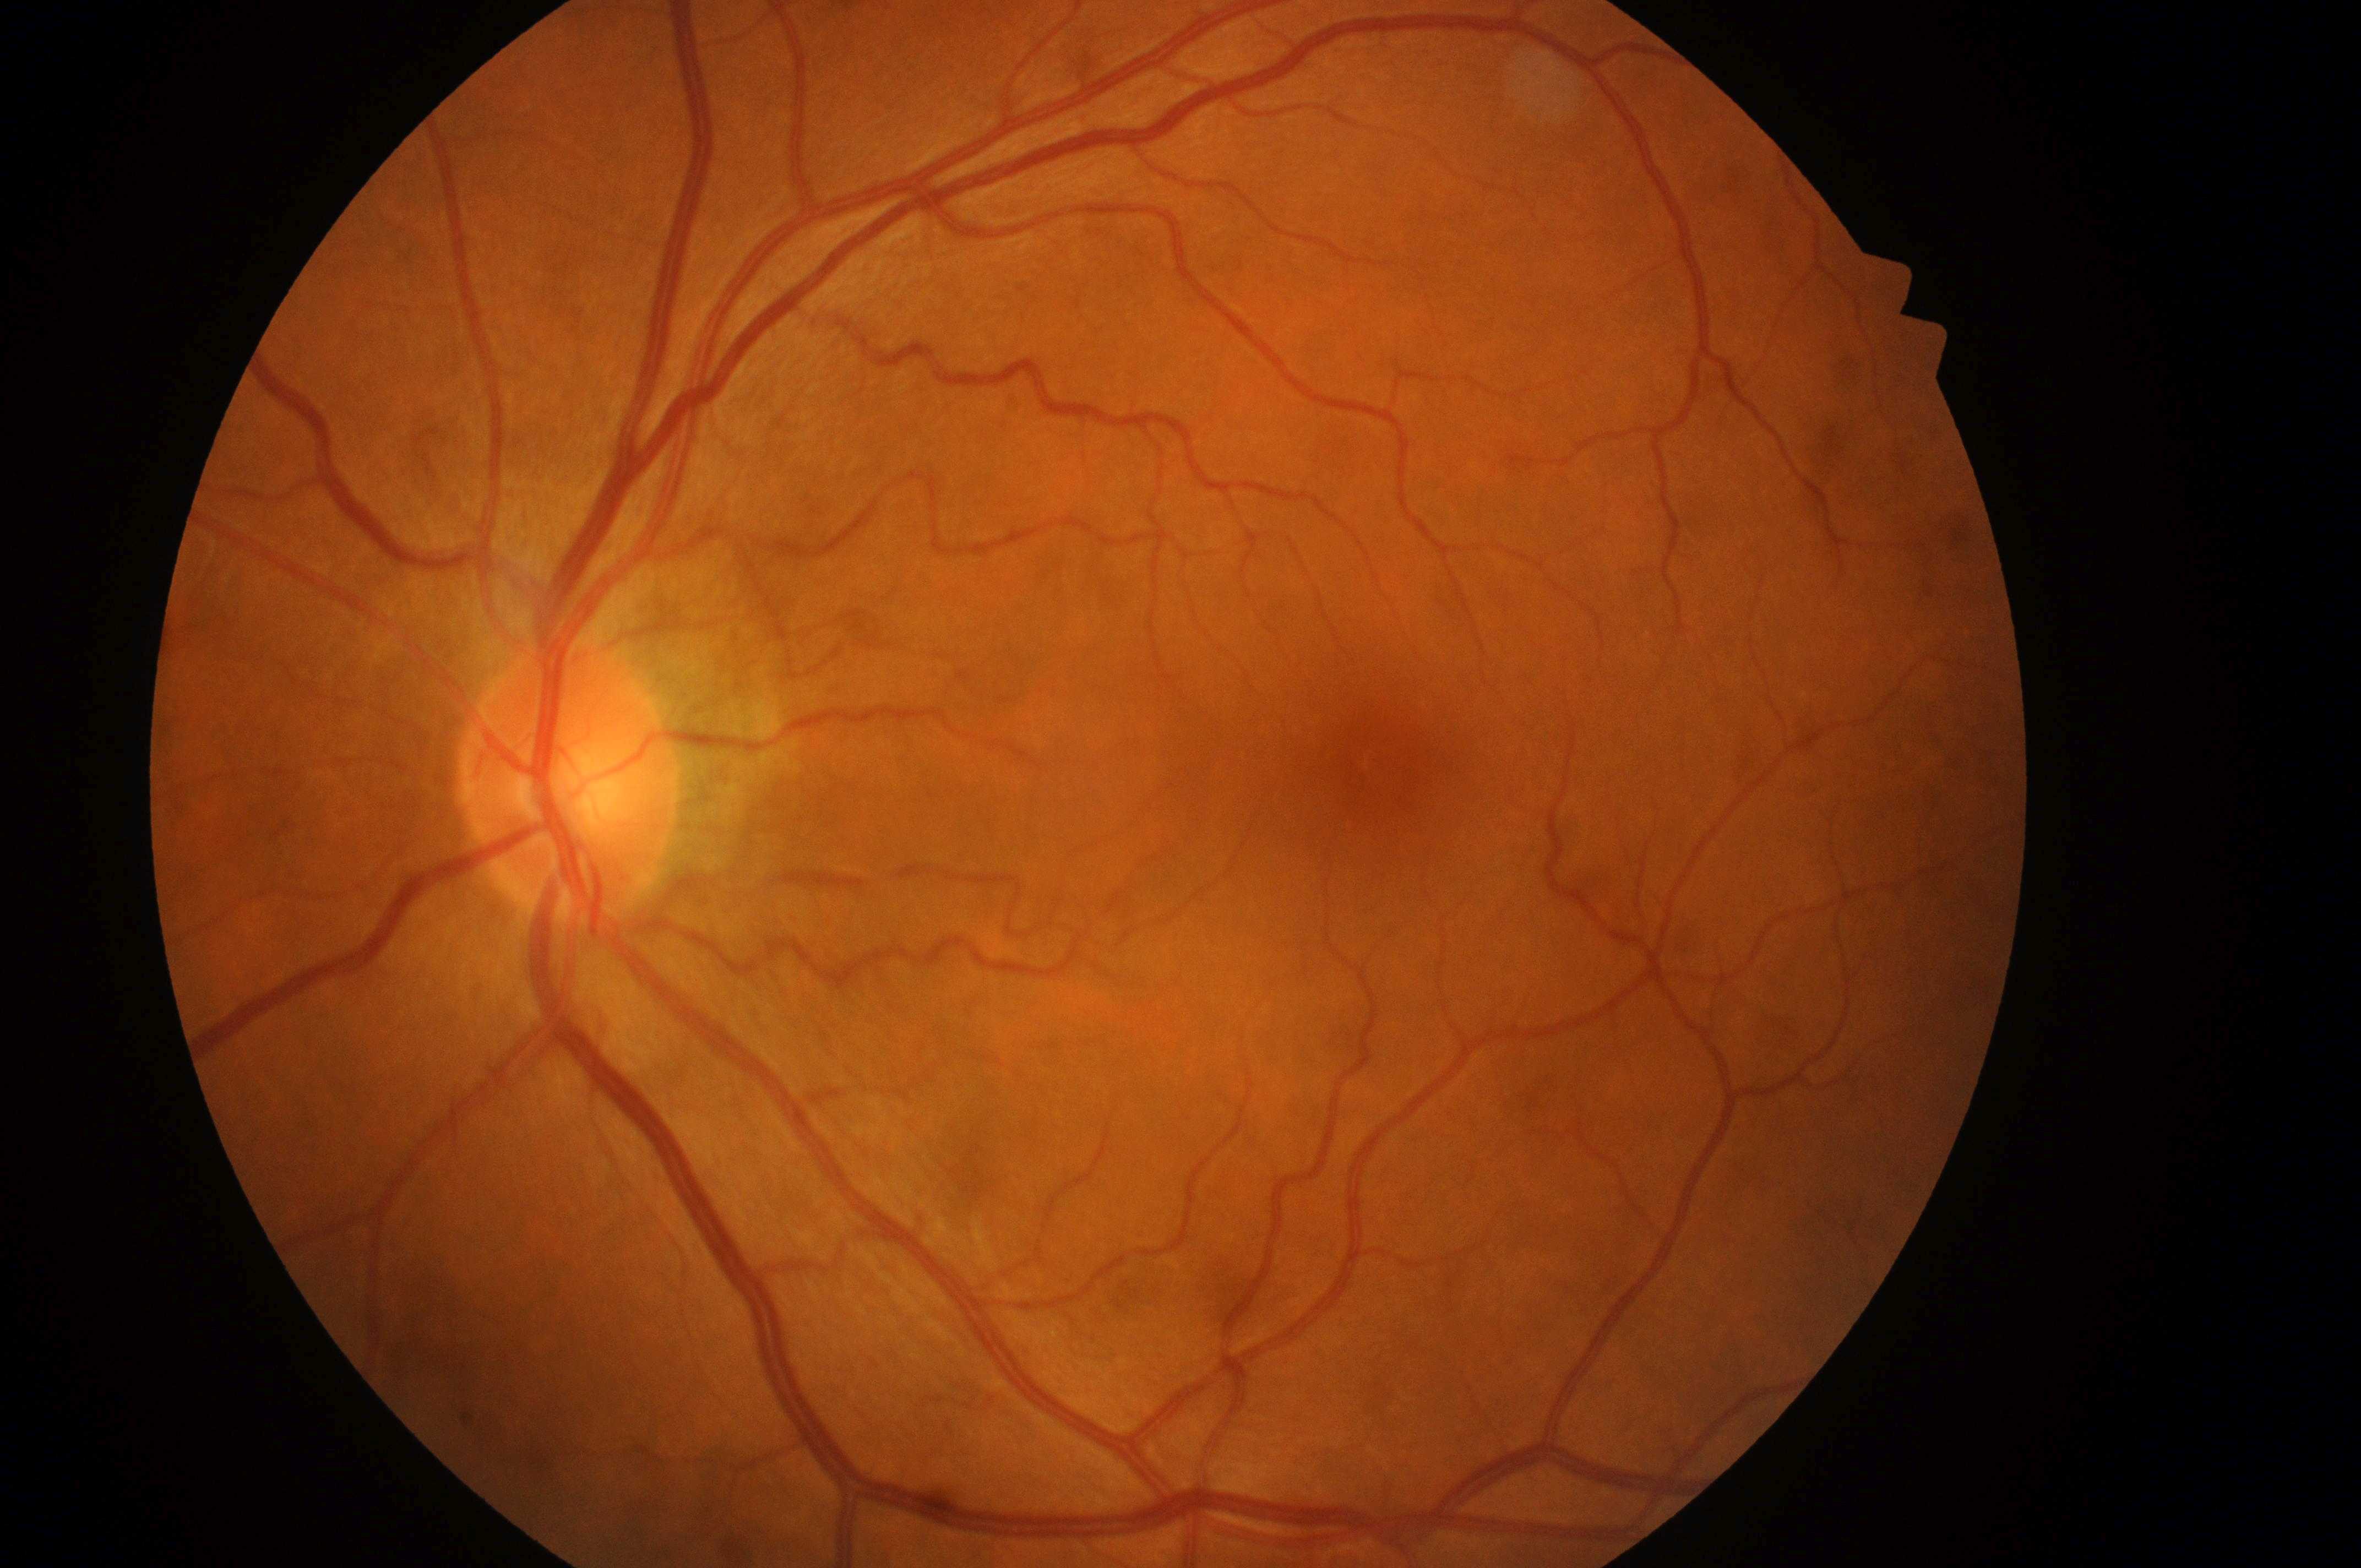

Fovea: x=1382, y=783.
DME risk is grade 0 (no risk).
No apparent diabetic retinopathy or macular edema.
Optic disk: x=563, y=796.
DR grade: 0 (no apparent retinopathy).
Imaged eye: oculus sinister.